Camera: Clarity RetCam 3 (130° FOV) · 640x480px · wide-field contact fundus photograph of an infant:
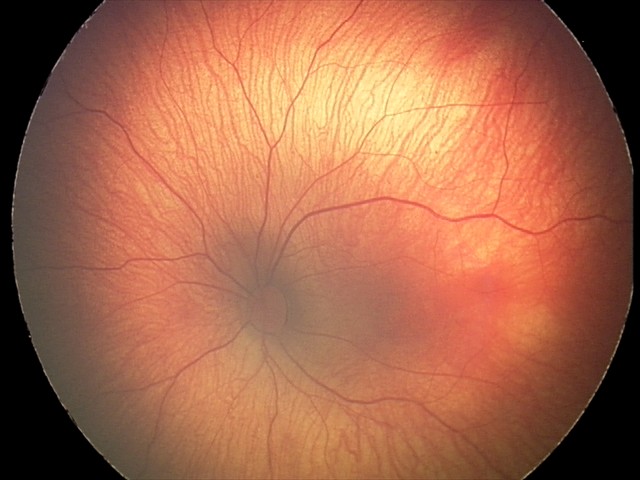 Diagnosis from this screening exam: retinal hemorrhages.